Modified Davis classification
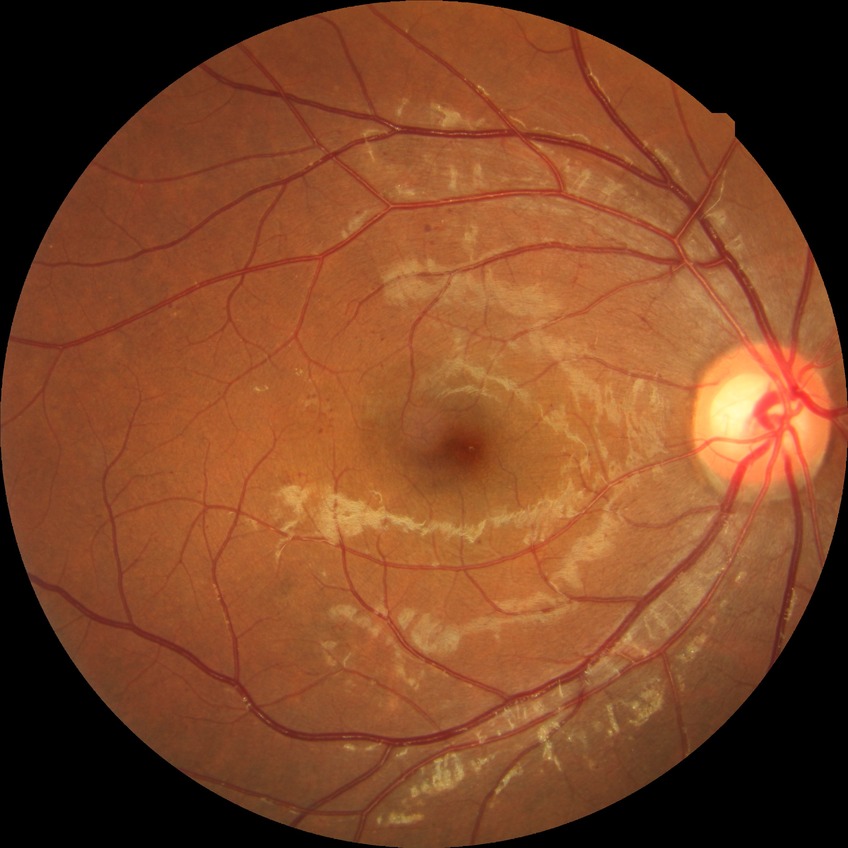 diabetic retinopathy (DR)@SDR (simple diabetic retinopathy).